NIDEK AFC-230.
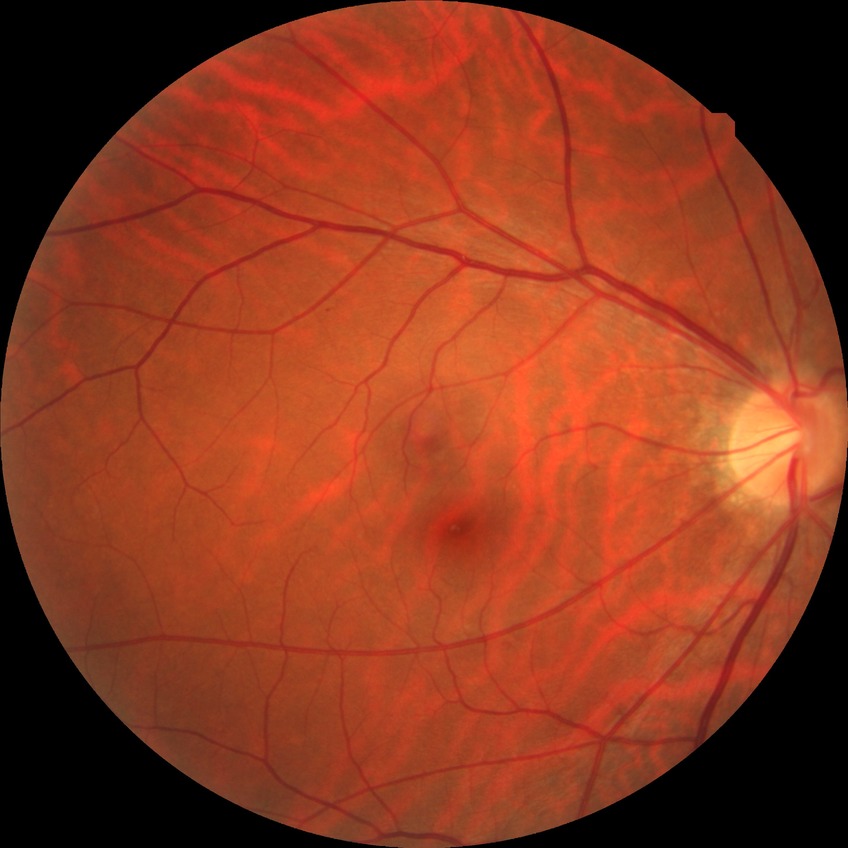

  davis_grade: NDR (no diabetic retinopathy)